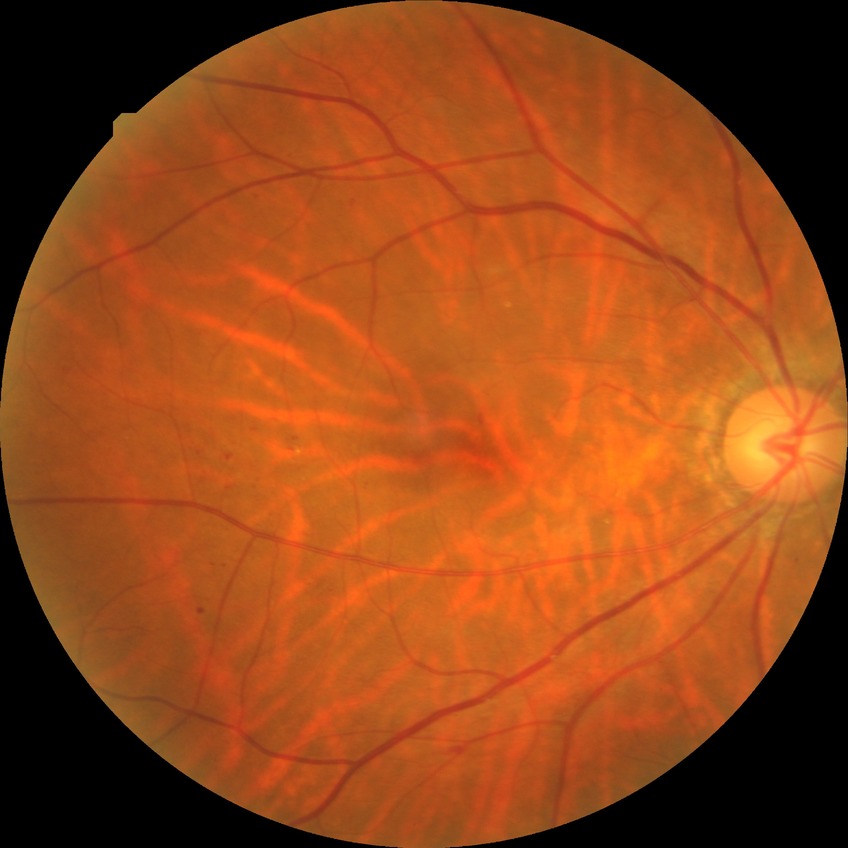
DR grade is SDR.